1924 x 1556 pixels; CFP
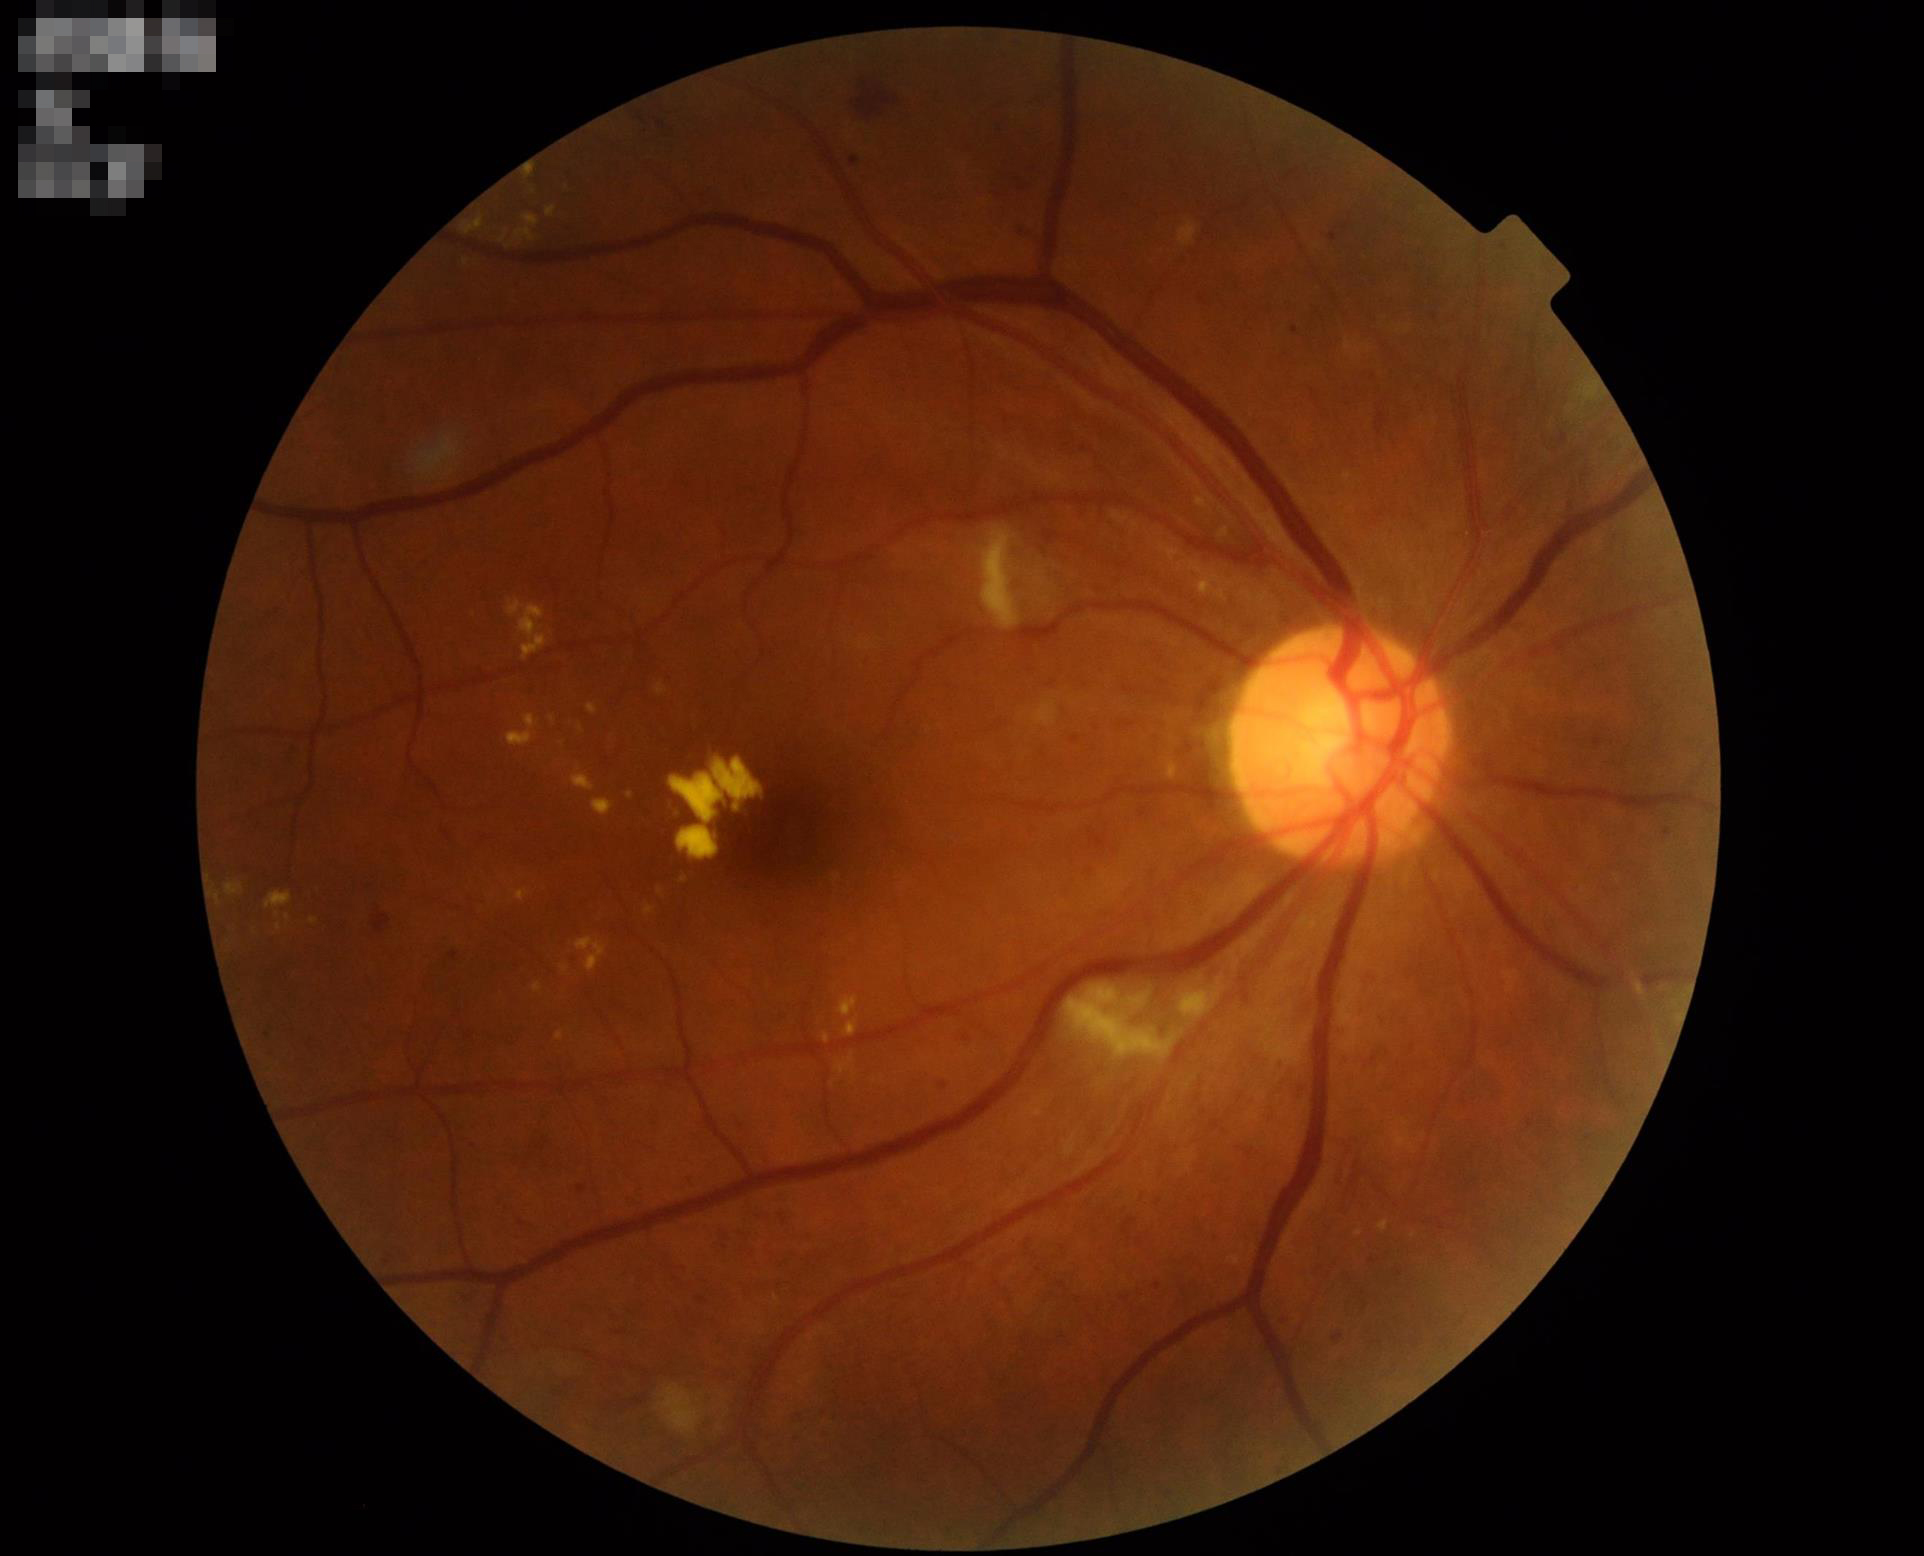 Image quality is adequate for diagnostic use. Illumination and color balance are good. Adequate contrast for distinguishing structures. The image is clear.